FOV: 50 degrees
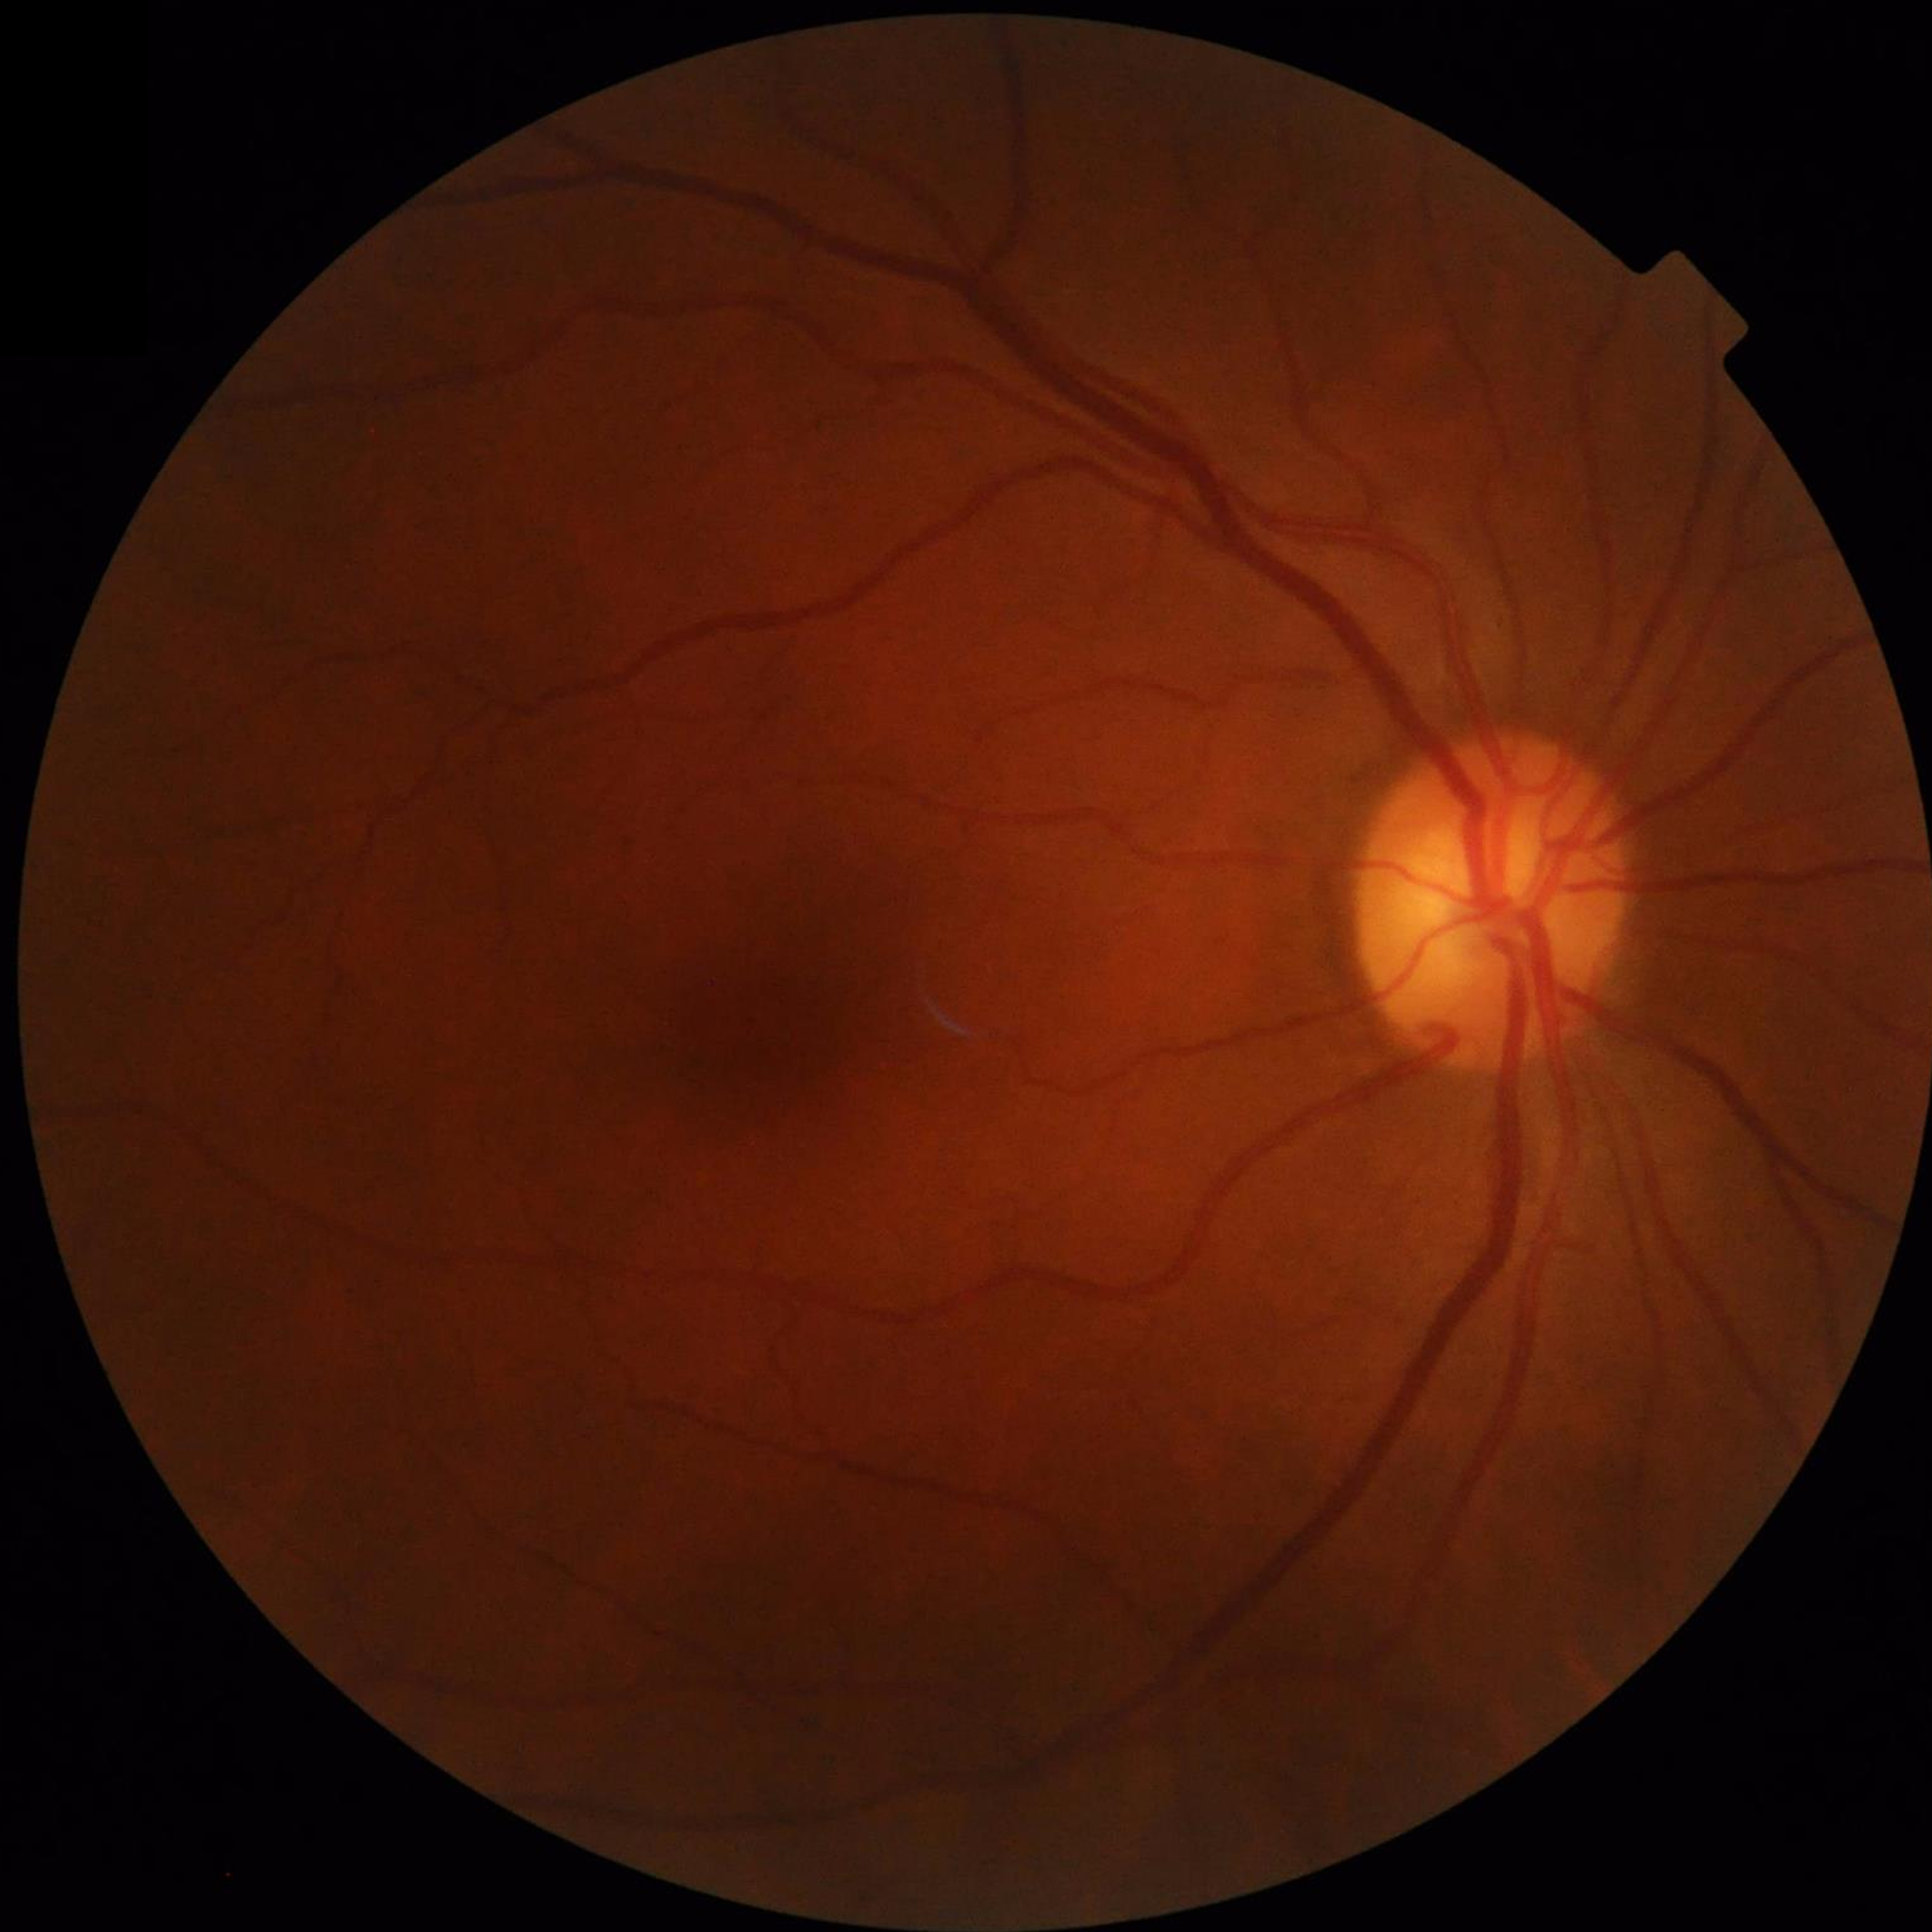

Disease class: no AMD, diabetic retinopathy, or glaucoma | Quality assessment: good.